Retinal fundus photograph; modified Davis grading; nonmydriatic fundus photograph; 45° field of view; 848x848; NIDEK AFC-230 fundus camera.
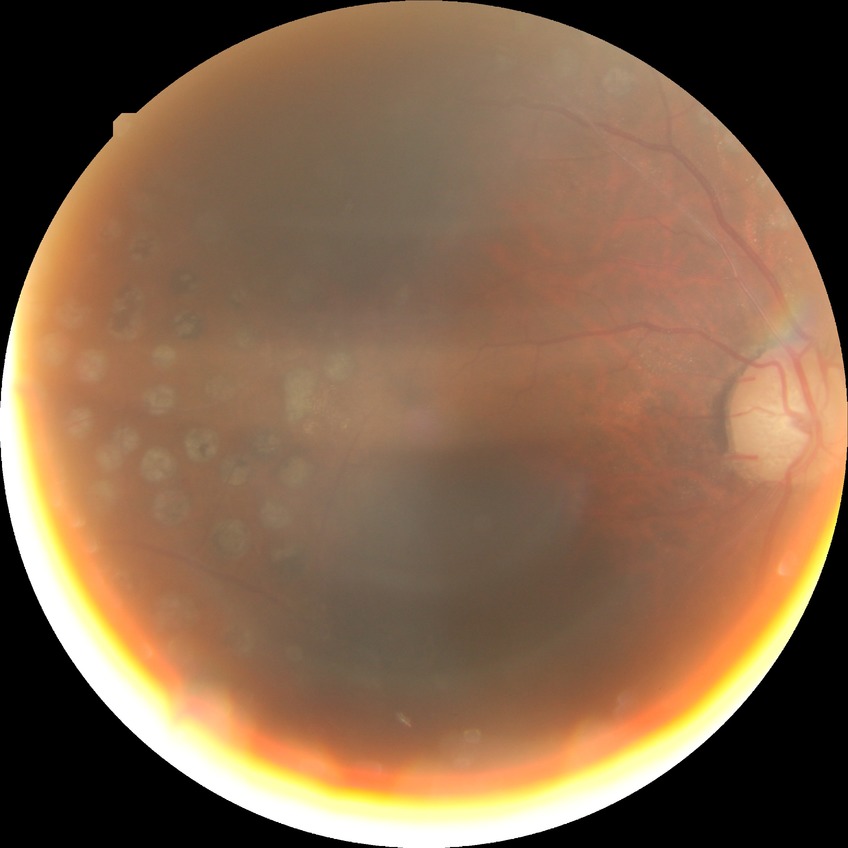 Davis grade: PDR.